640 x 480 pixels. 130° field of view (Clarity RetCam 3). Pediatric retinal photograph (wide-field)
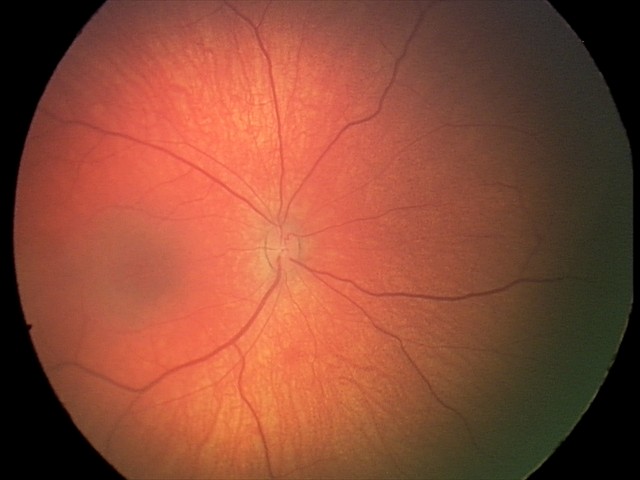

Assessment: no abnormal retinal findings.